Wide-field fundus photograph of an infant:
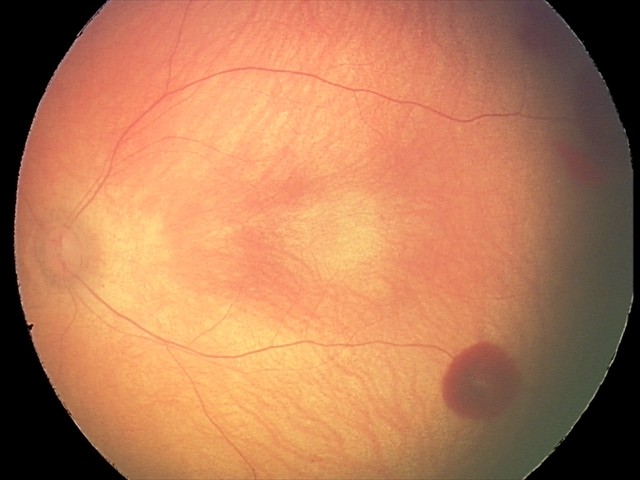
Screening diagnosis: retinal hemorrhages.